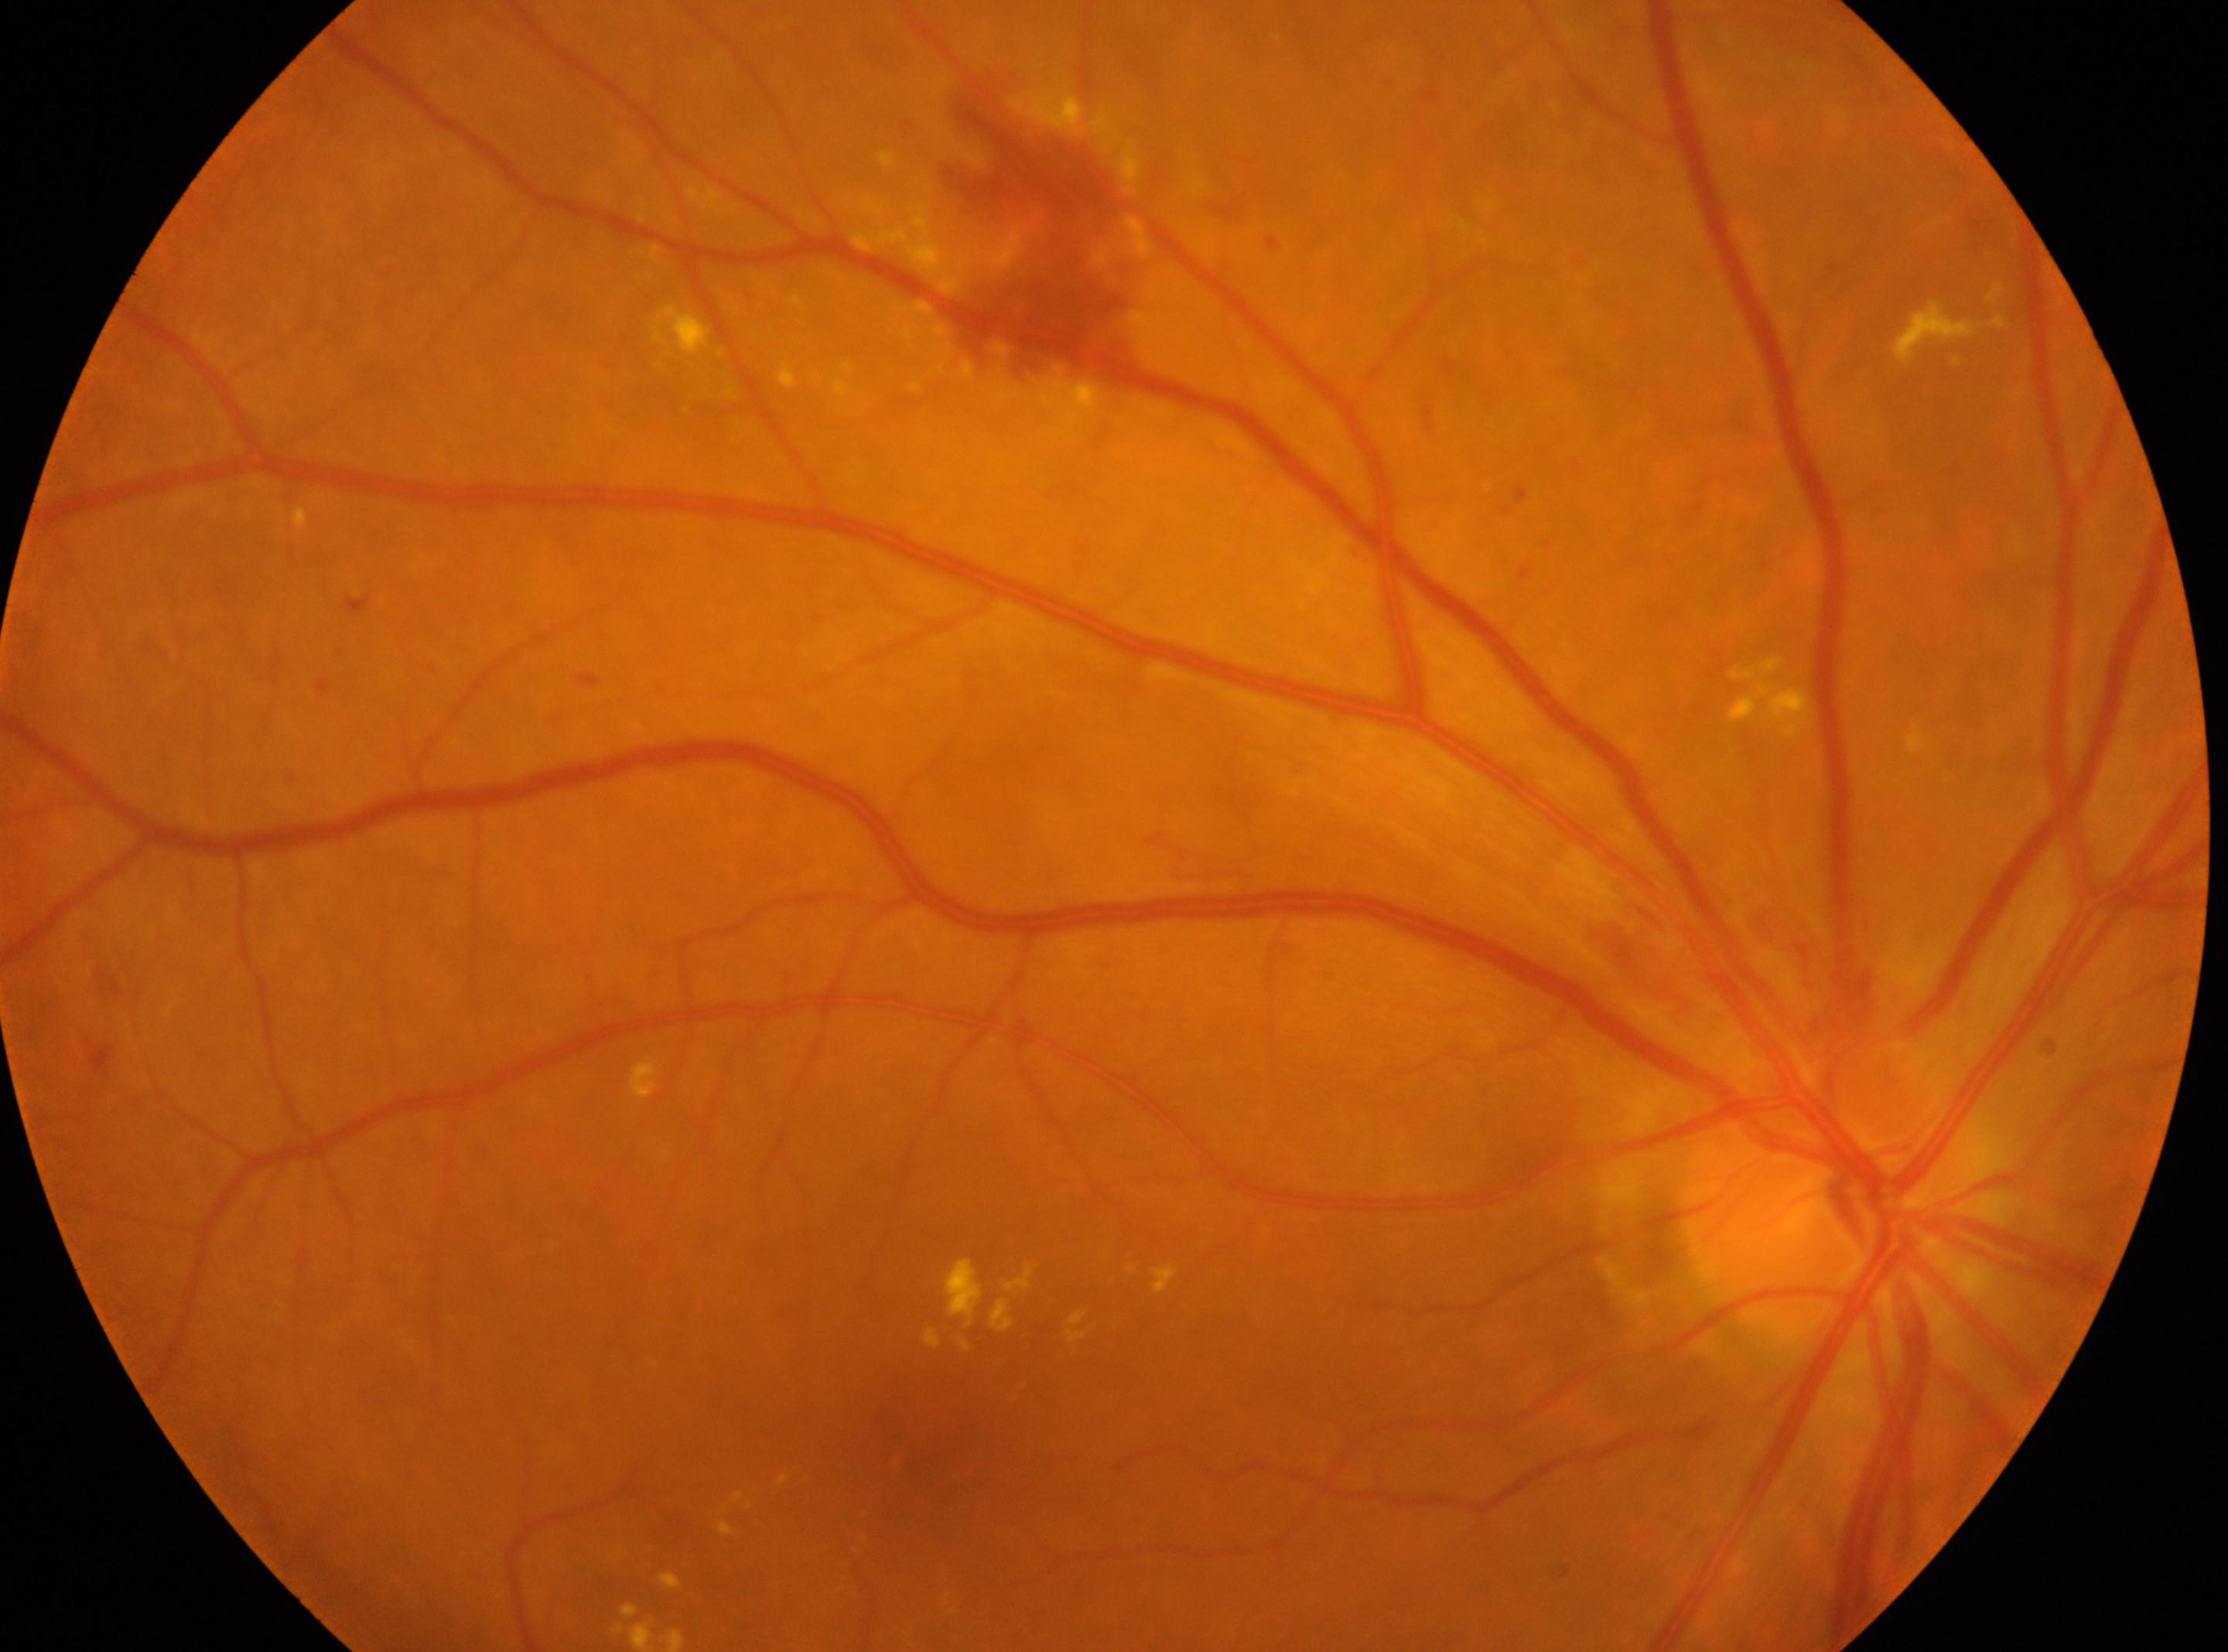
DR grade: moderate NPDR (2) | laterality: the right eye | foveal center: 913px, 1469px | the optic disc: 1814px, 1205px | DR class: non-proliferative diabetic retinopathy.